Infant wide-field retinal image. 1240x1240 — 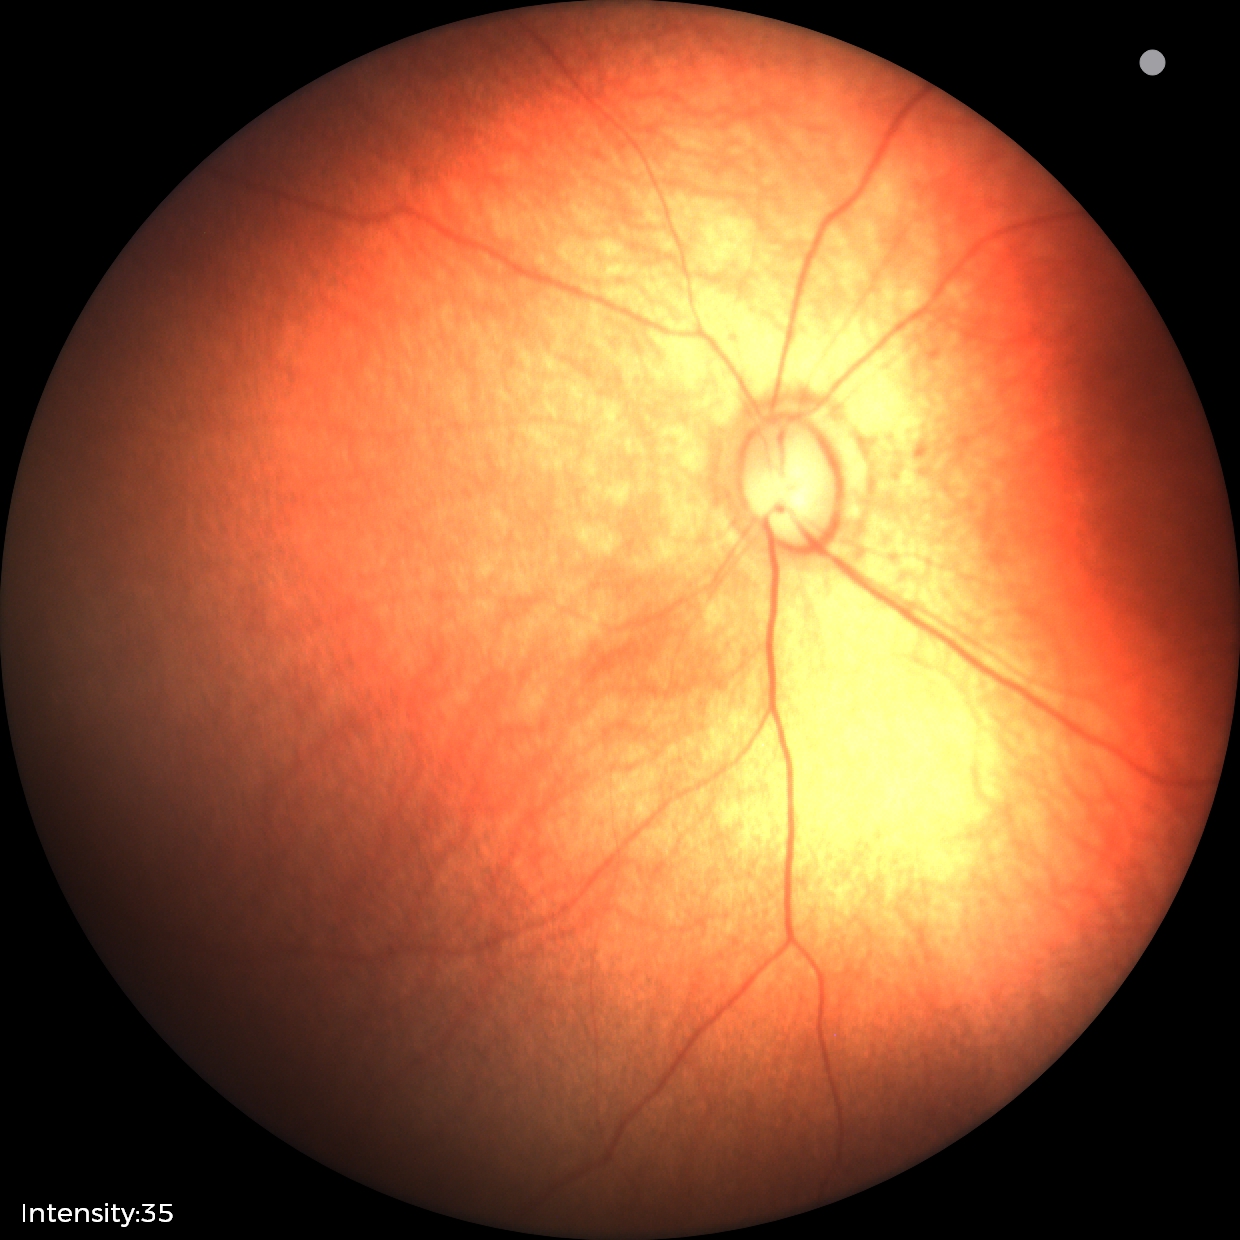
Screening examination diagnosed as physiological.